Pediatric wide-field fundus photograph: 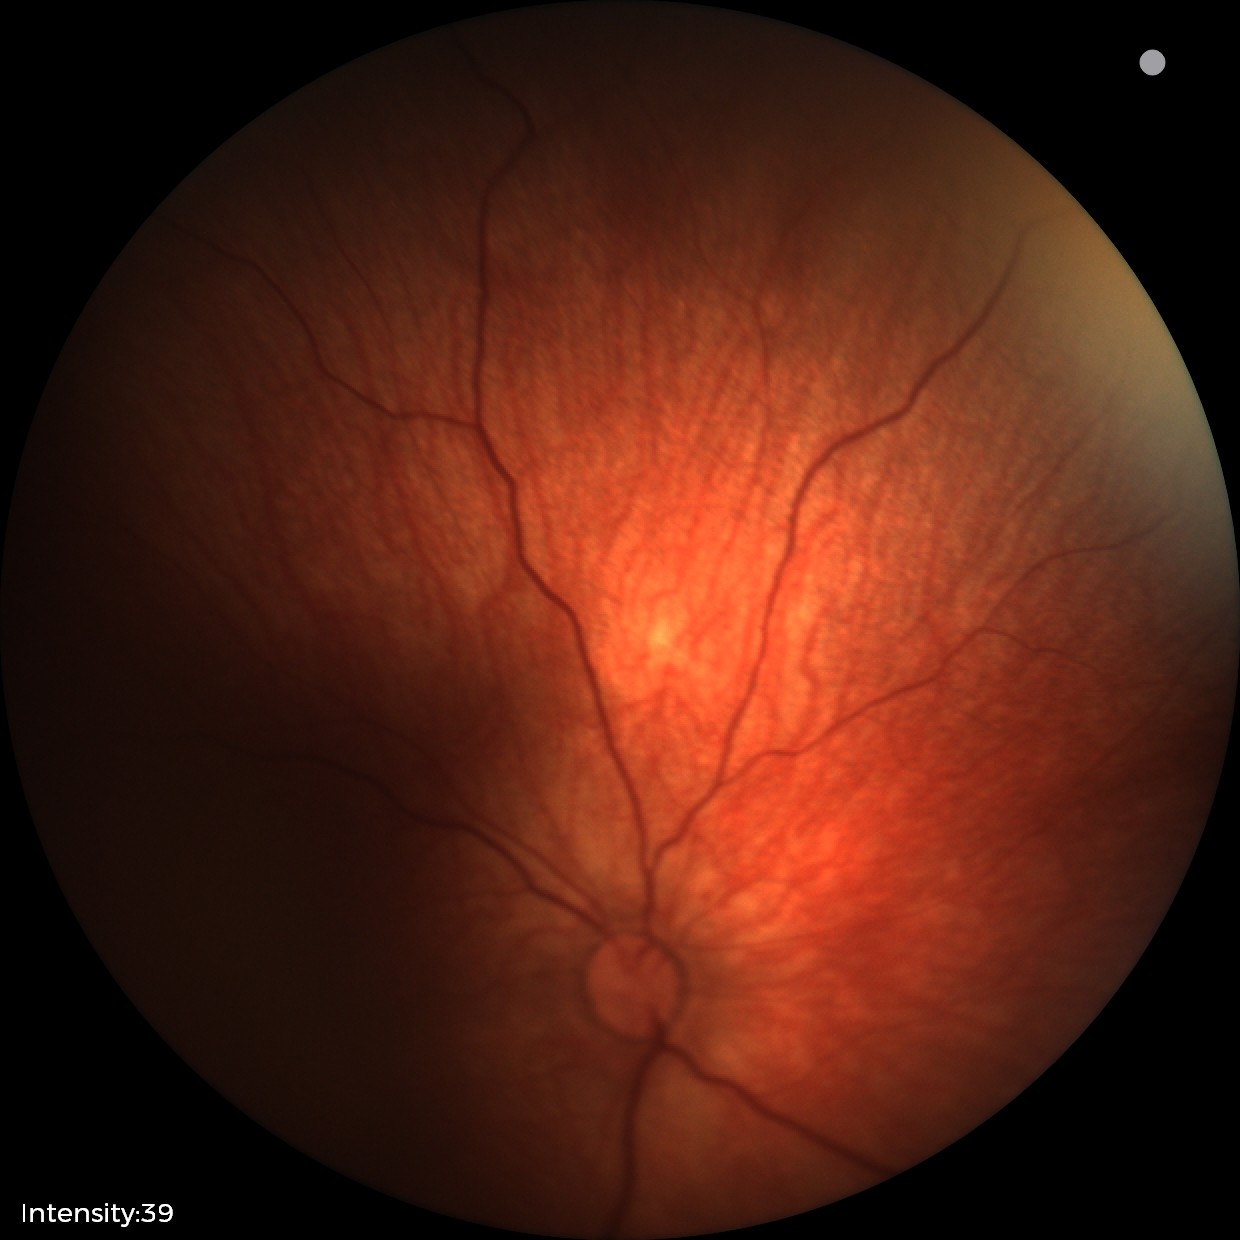

Screening examination diagnosed as physiological.